No pharmacologic dilation, modified Davis grading, 45° FOV, image size 848x848, camera: NIDEK AFC-230:
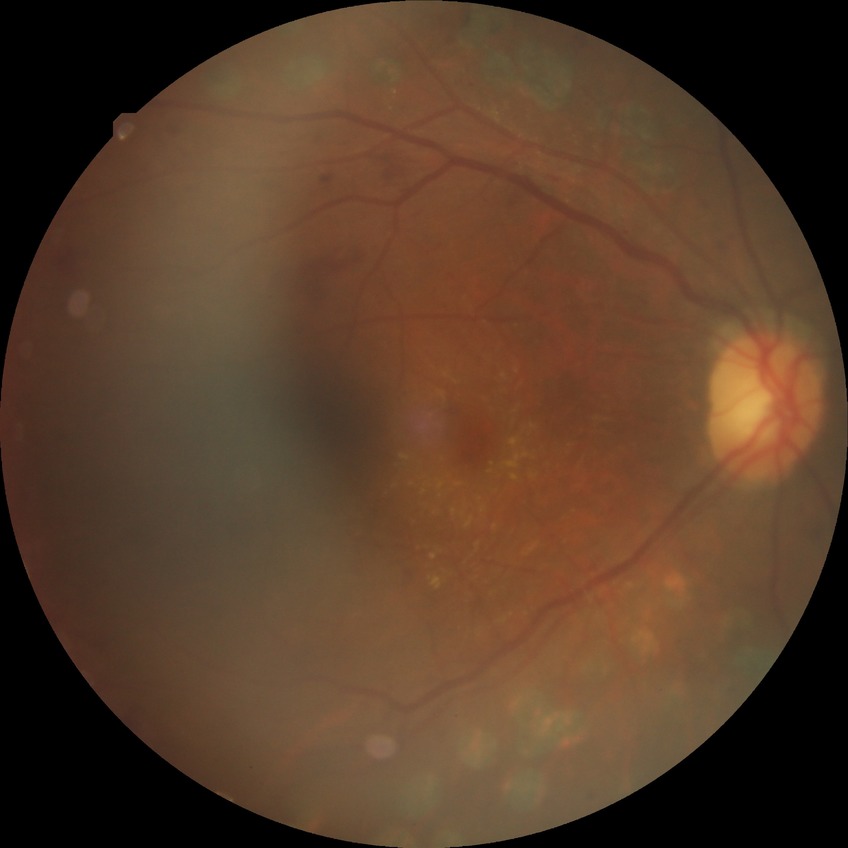 Diabetic retinopathy grade: proliferative diabetic retinopathy.